Natus RetCam Envision, 130° FOV. Infant wide-field retinal image.
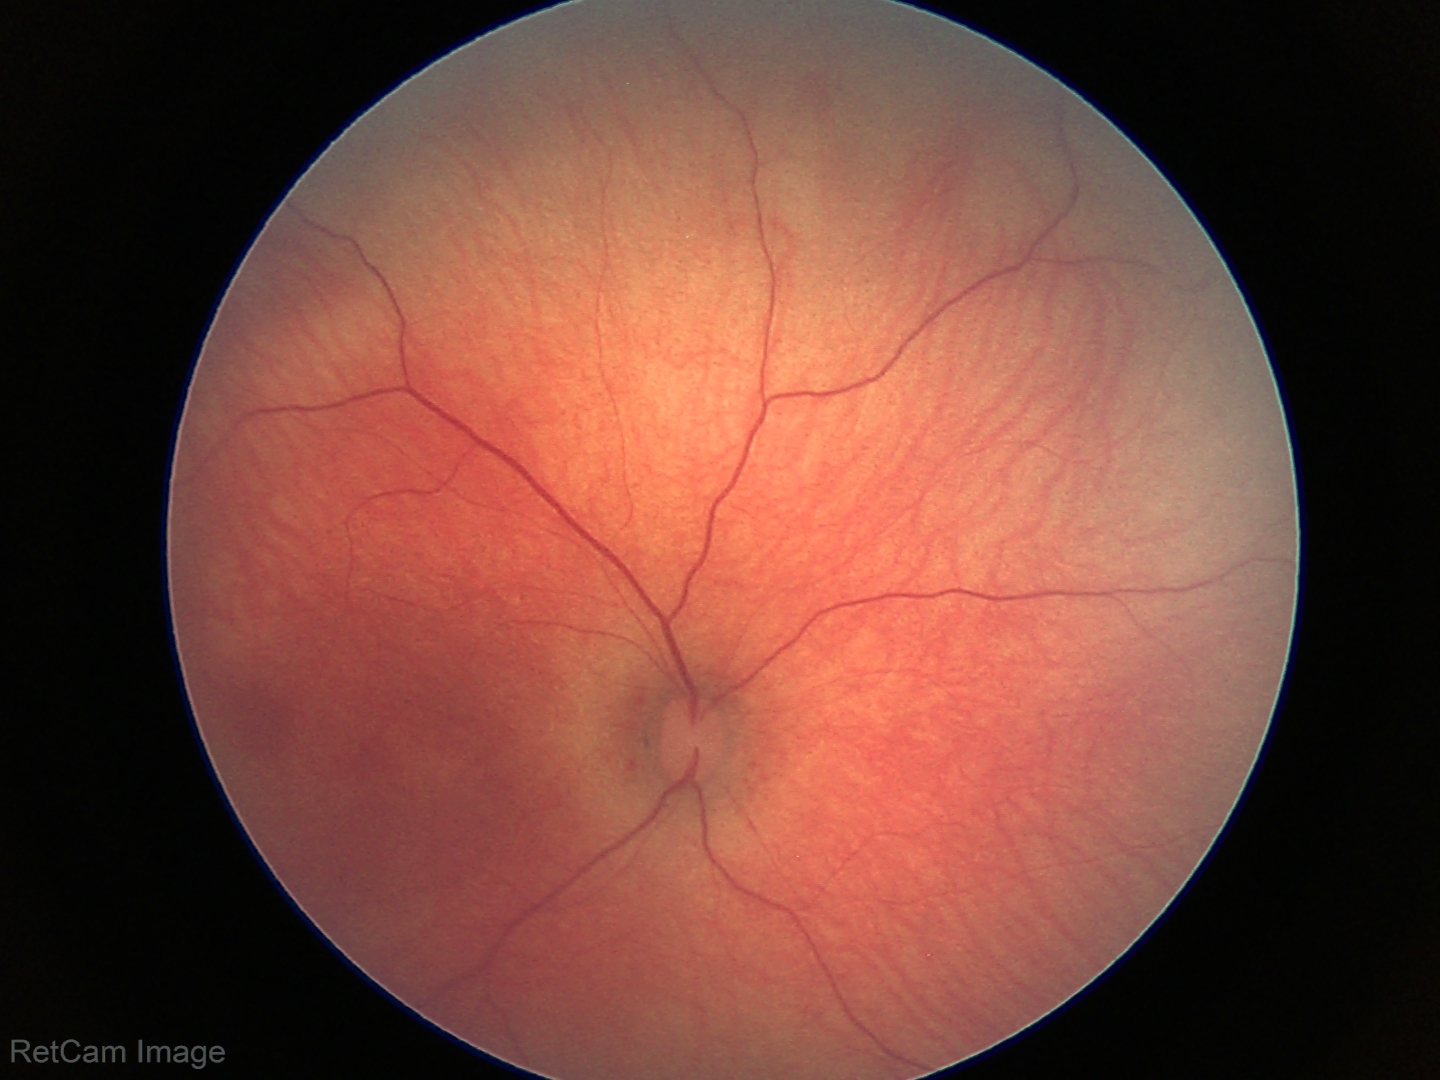
Q: What is the screening diagnosis?
A: physiological finding